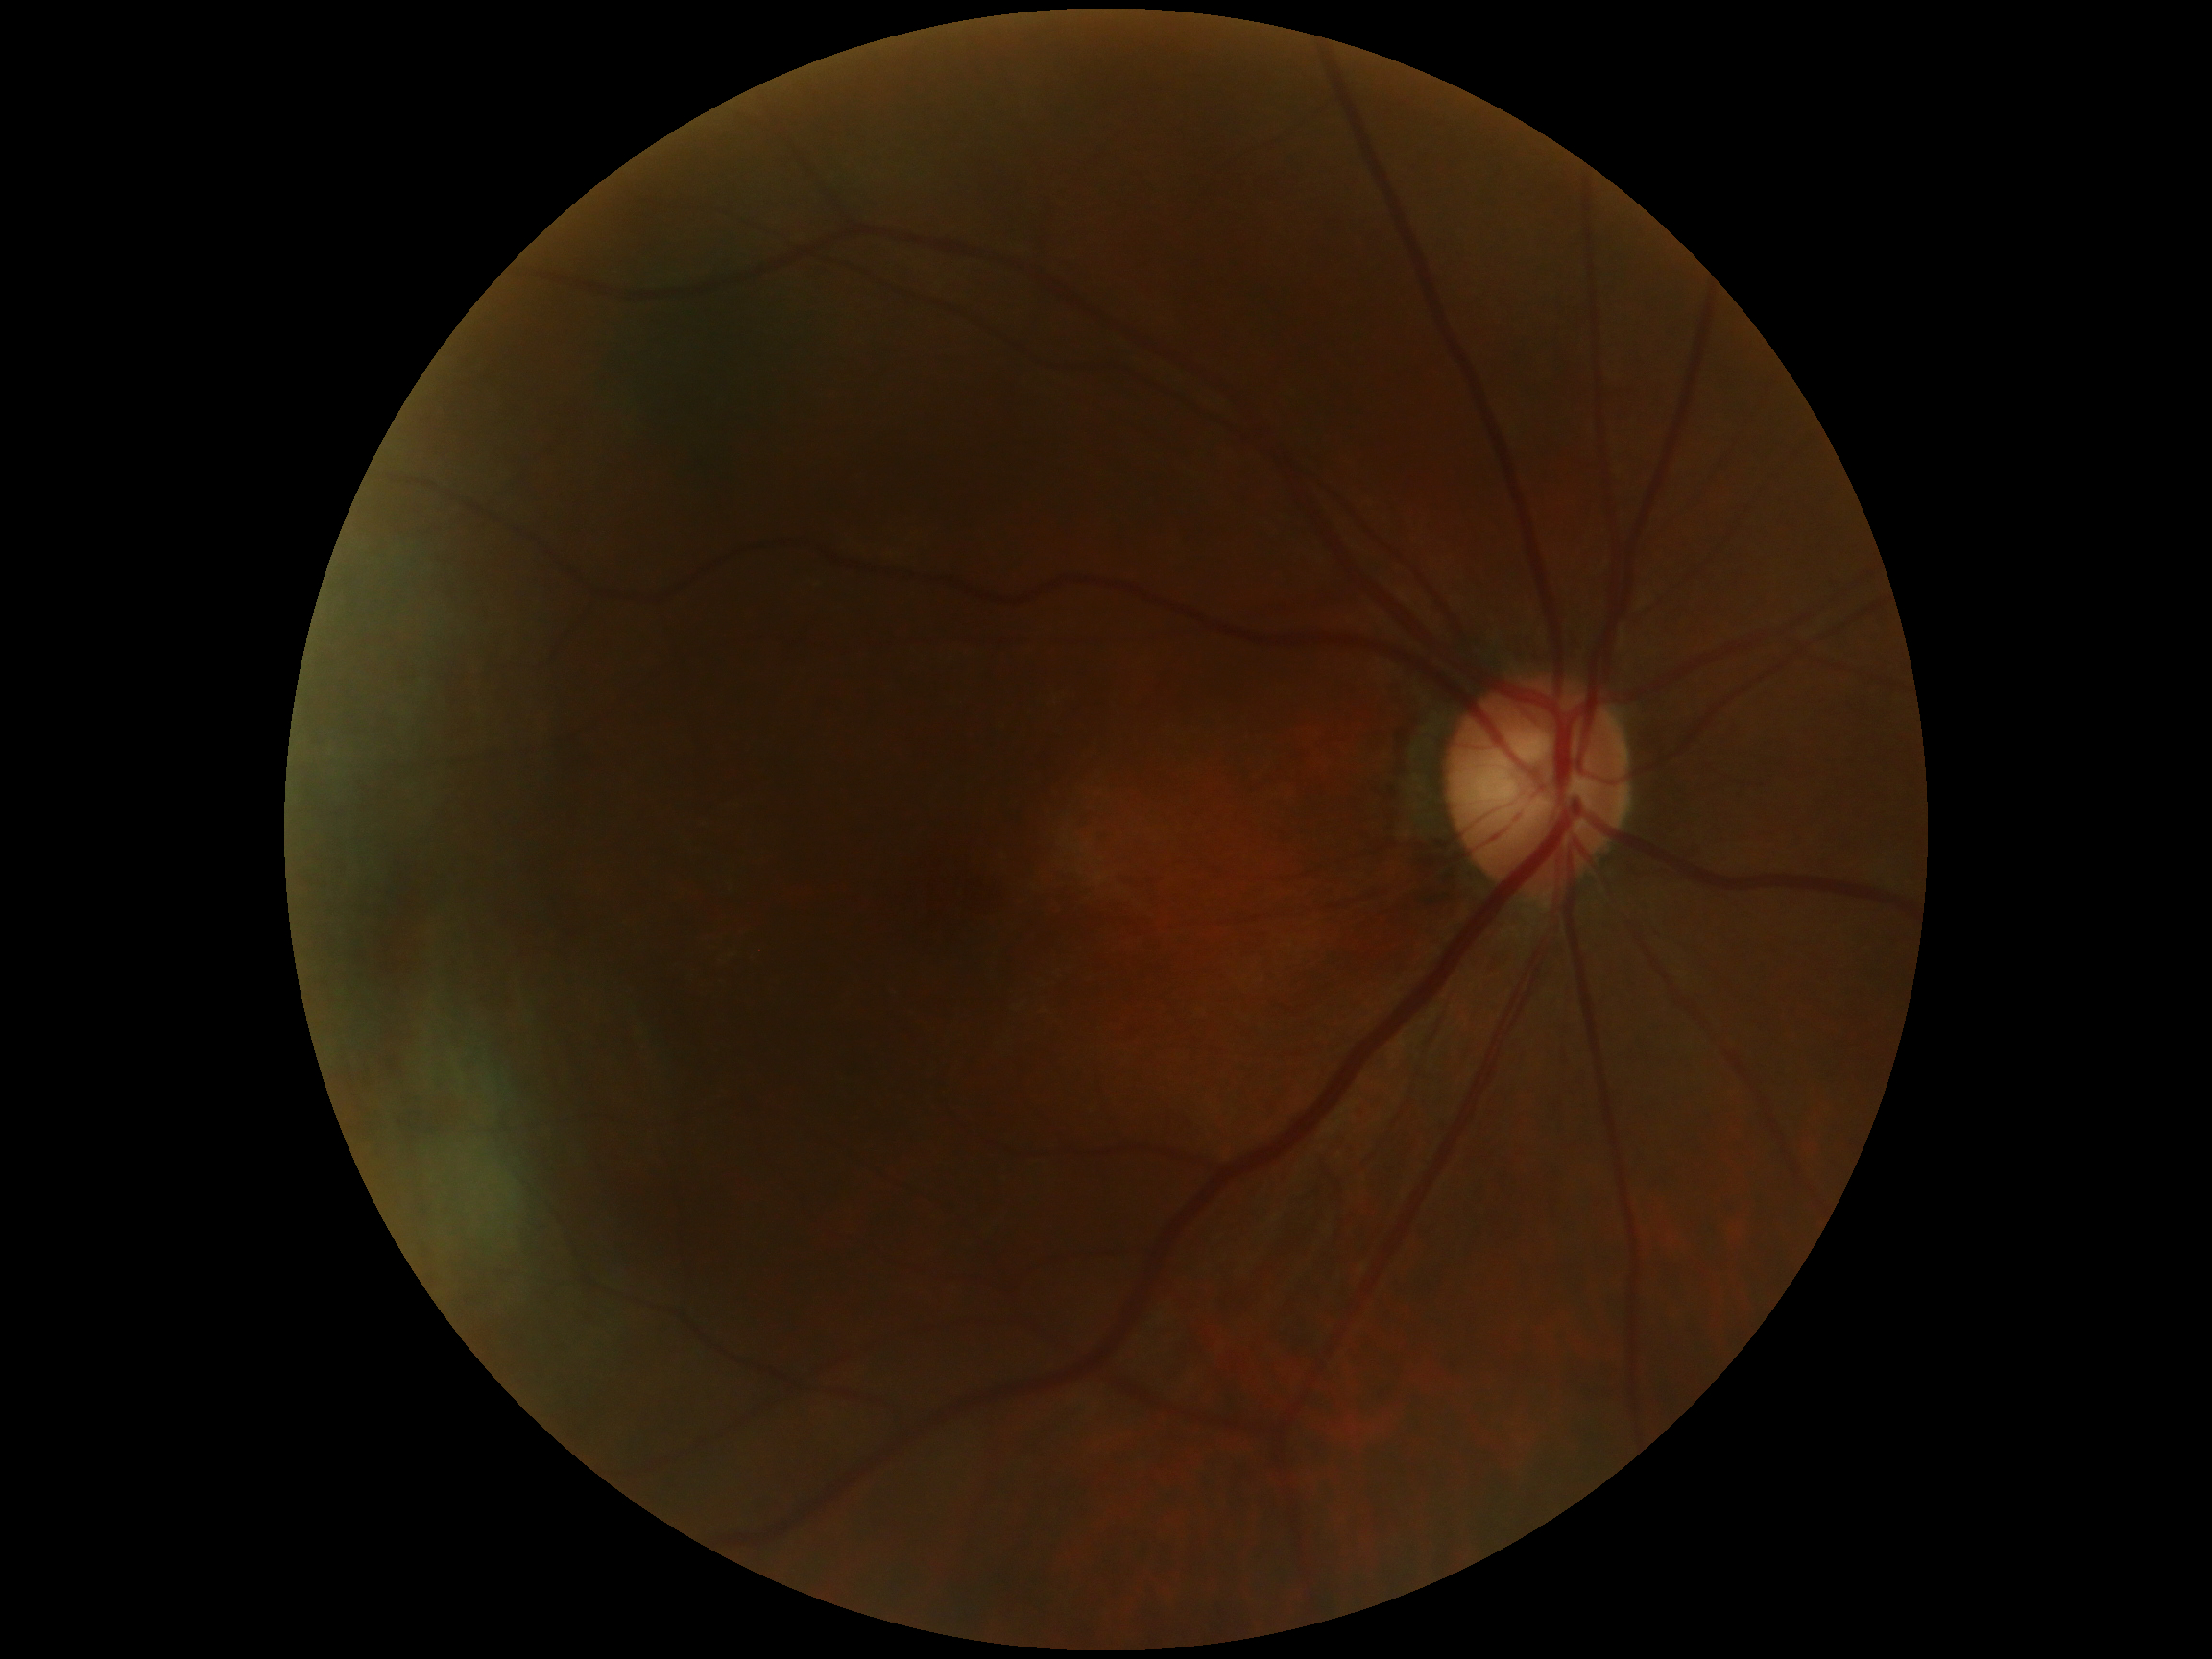 DR grade: no apparent retinopathy (0).
No diabetic retinal disease findings.